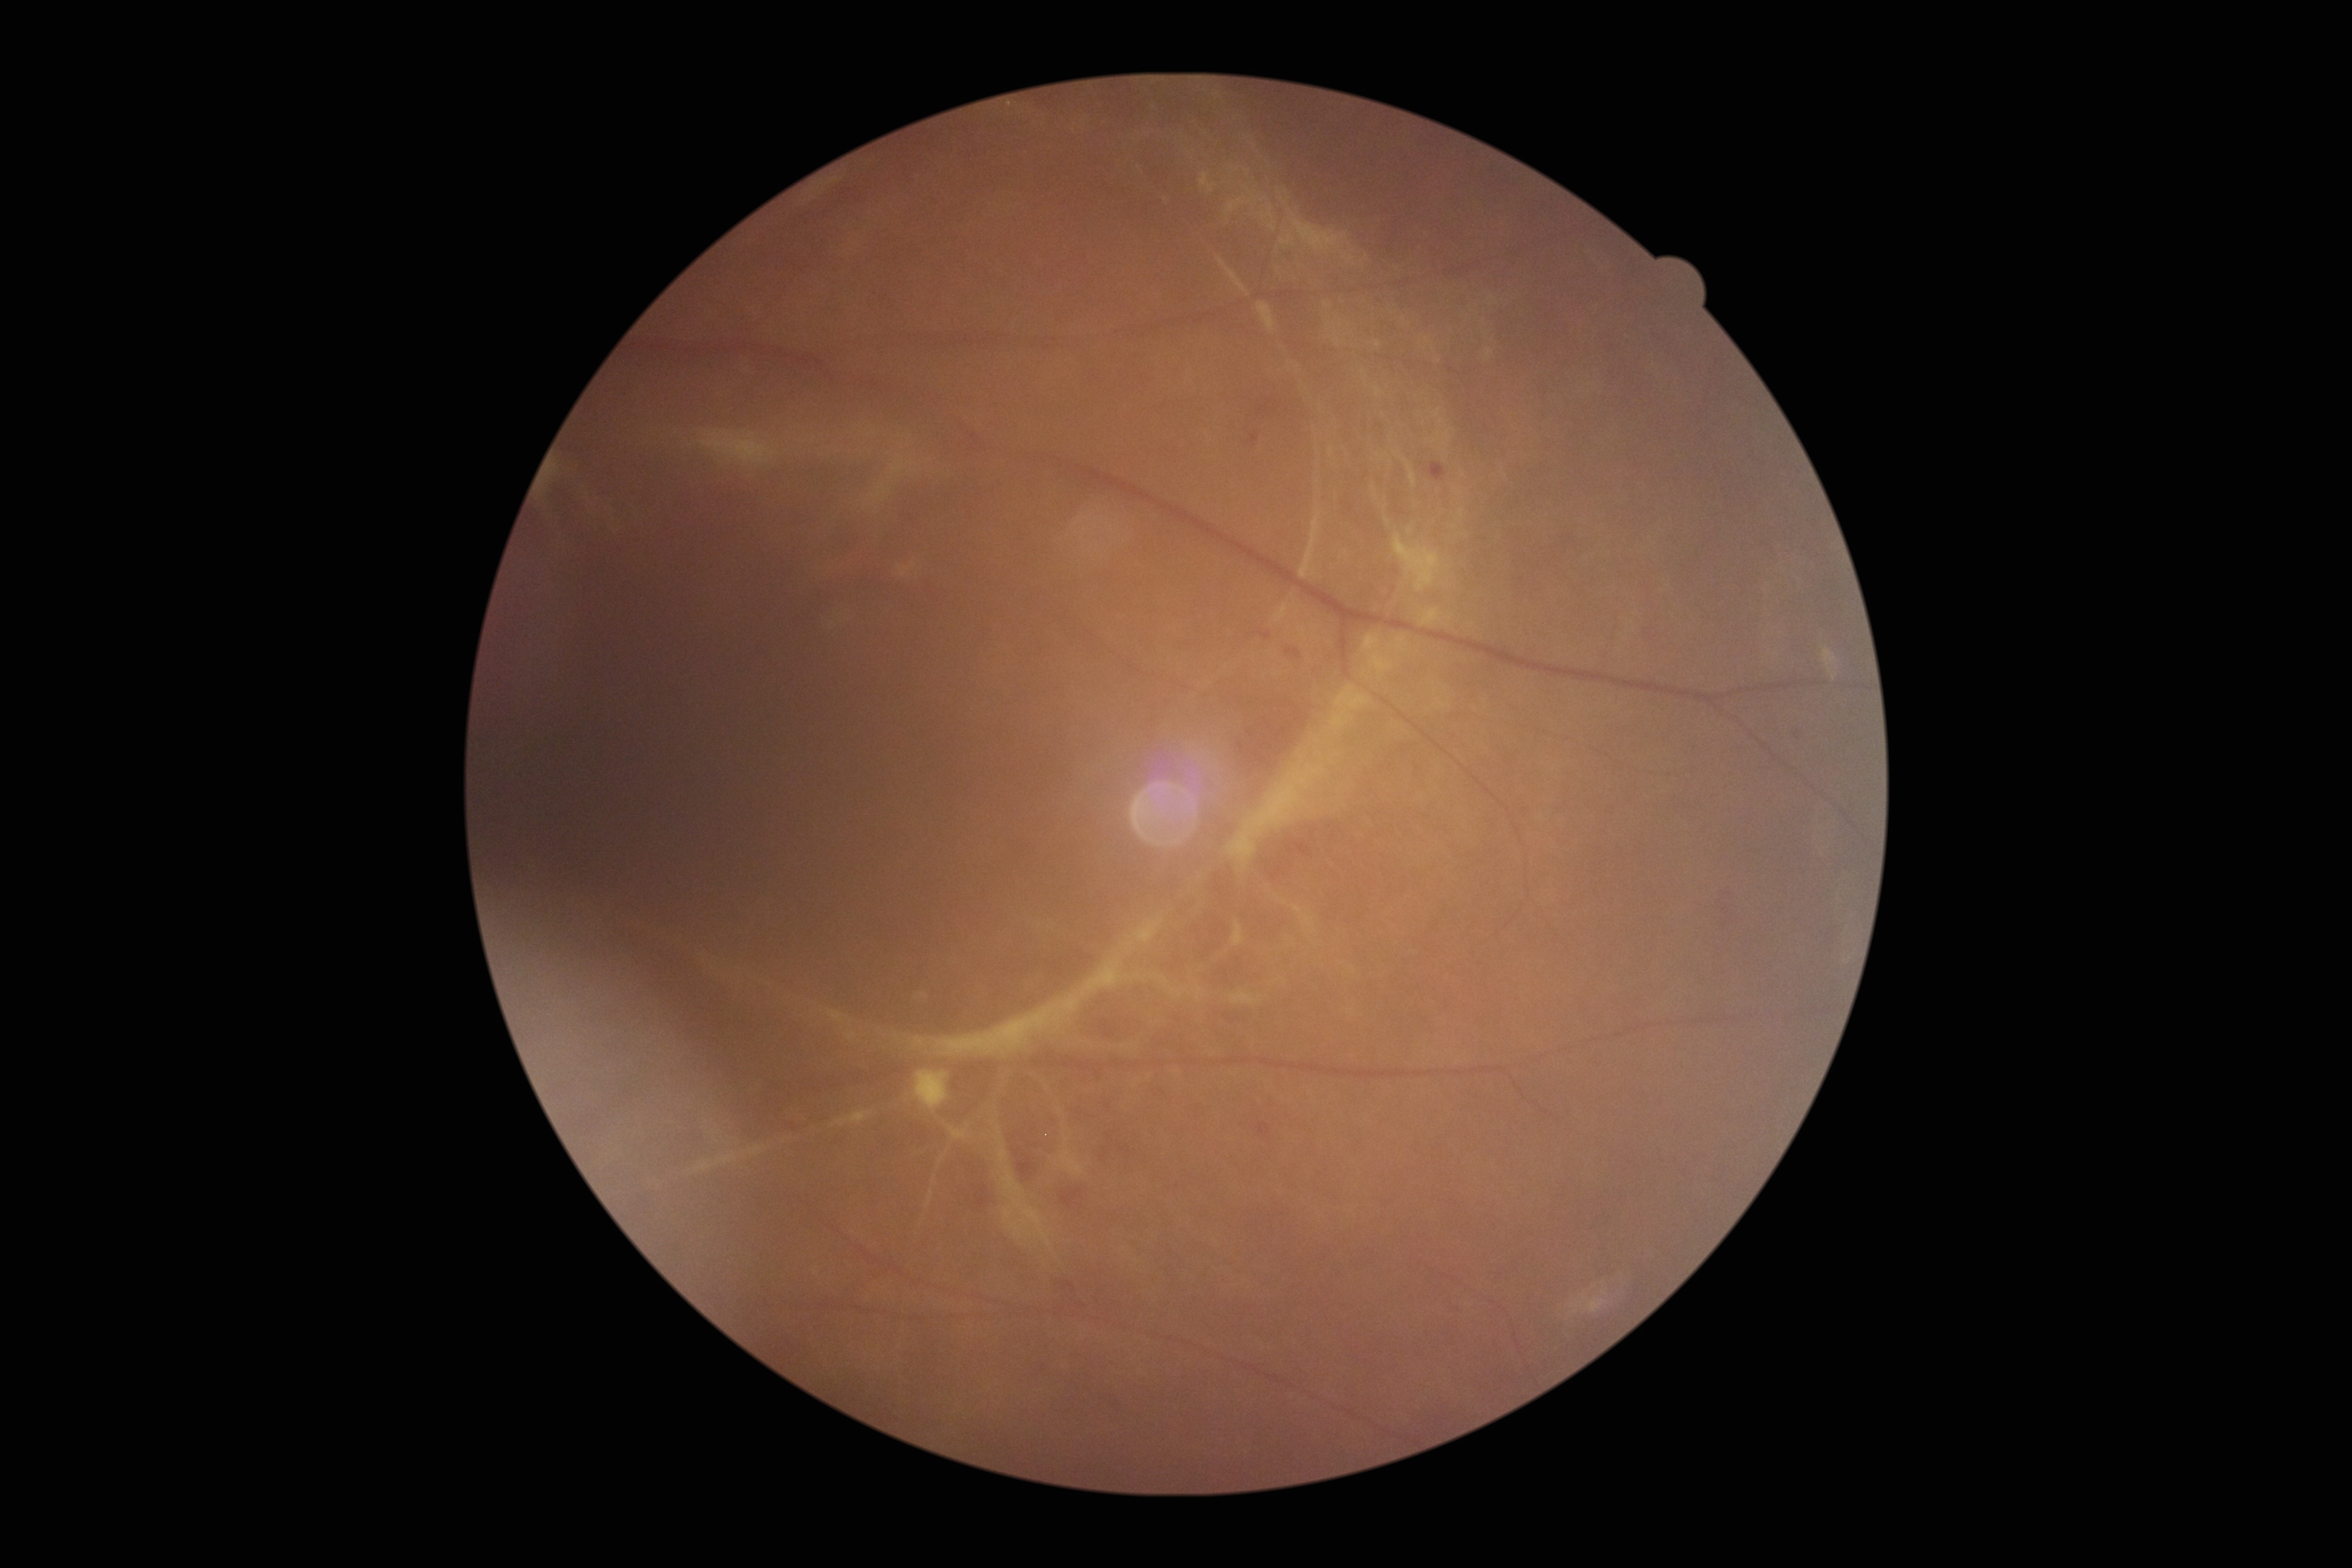 DR grade: 4/4 — neovascularization and/or vitreous/pre-retinal hemorrhage.